Fundus photo: 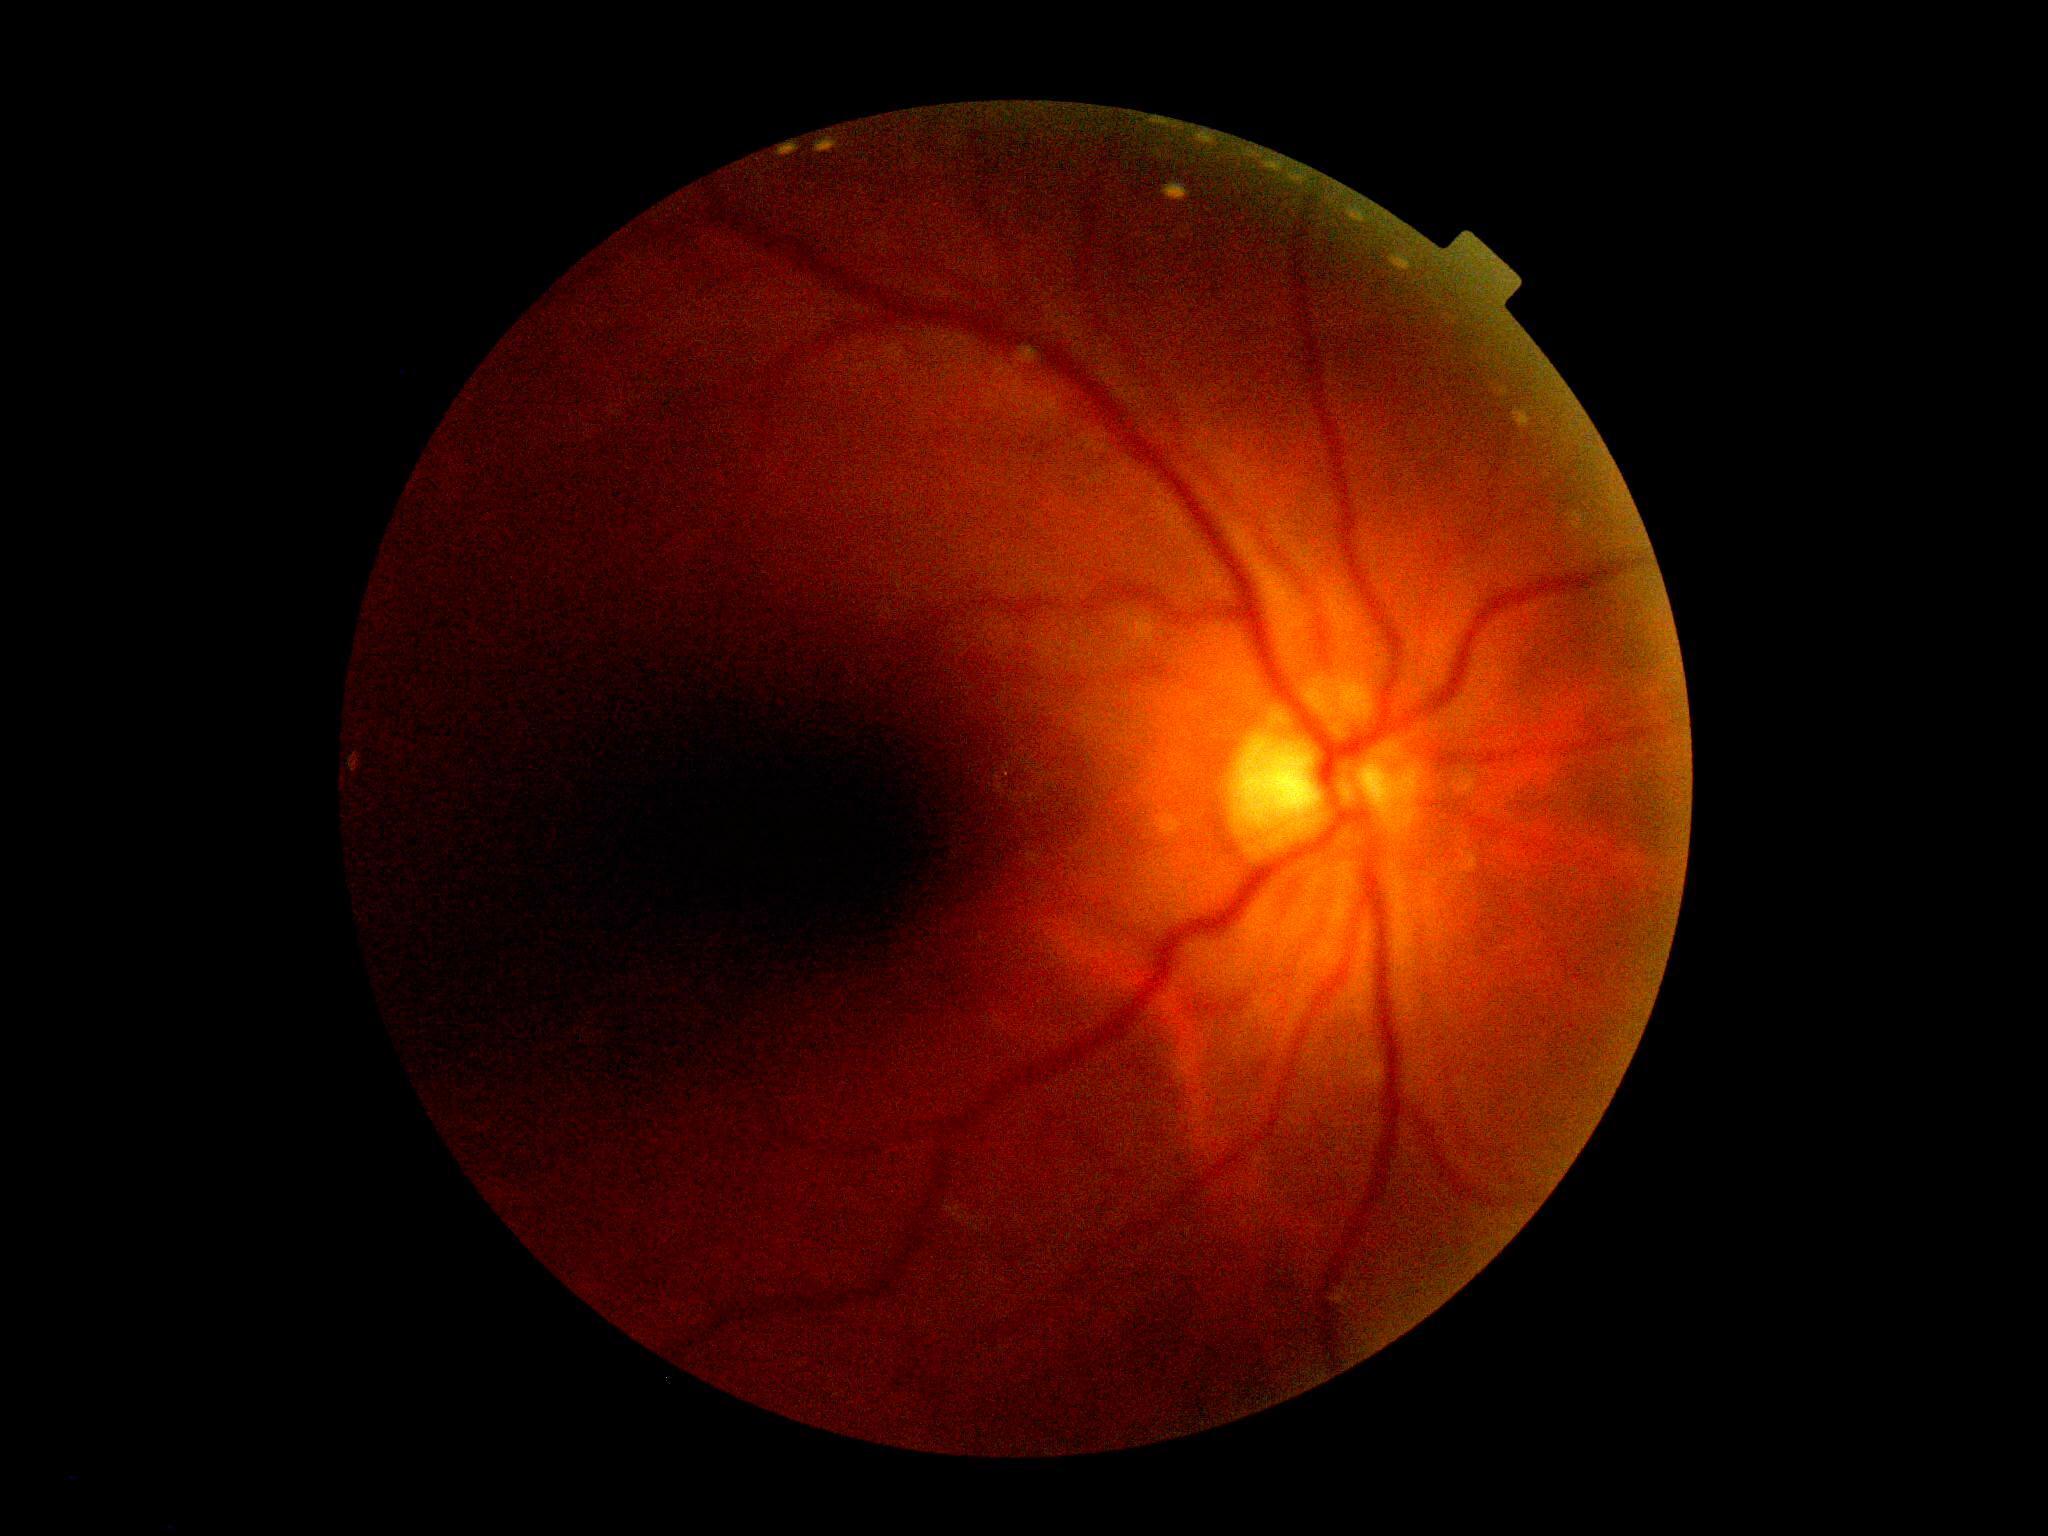 The image cannot be graded for diabetic retinopathy. DR stage: ungradable.